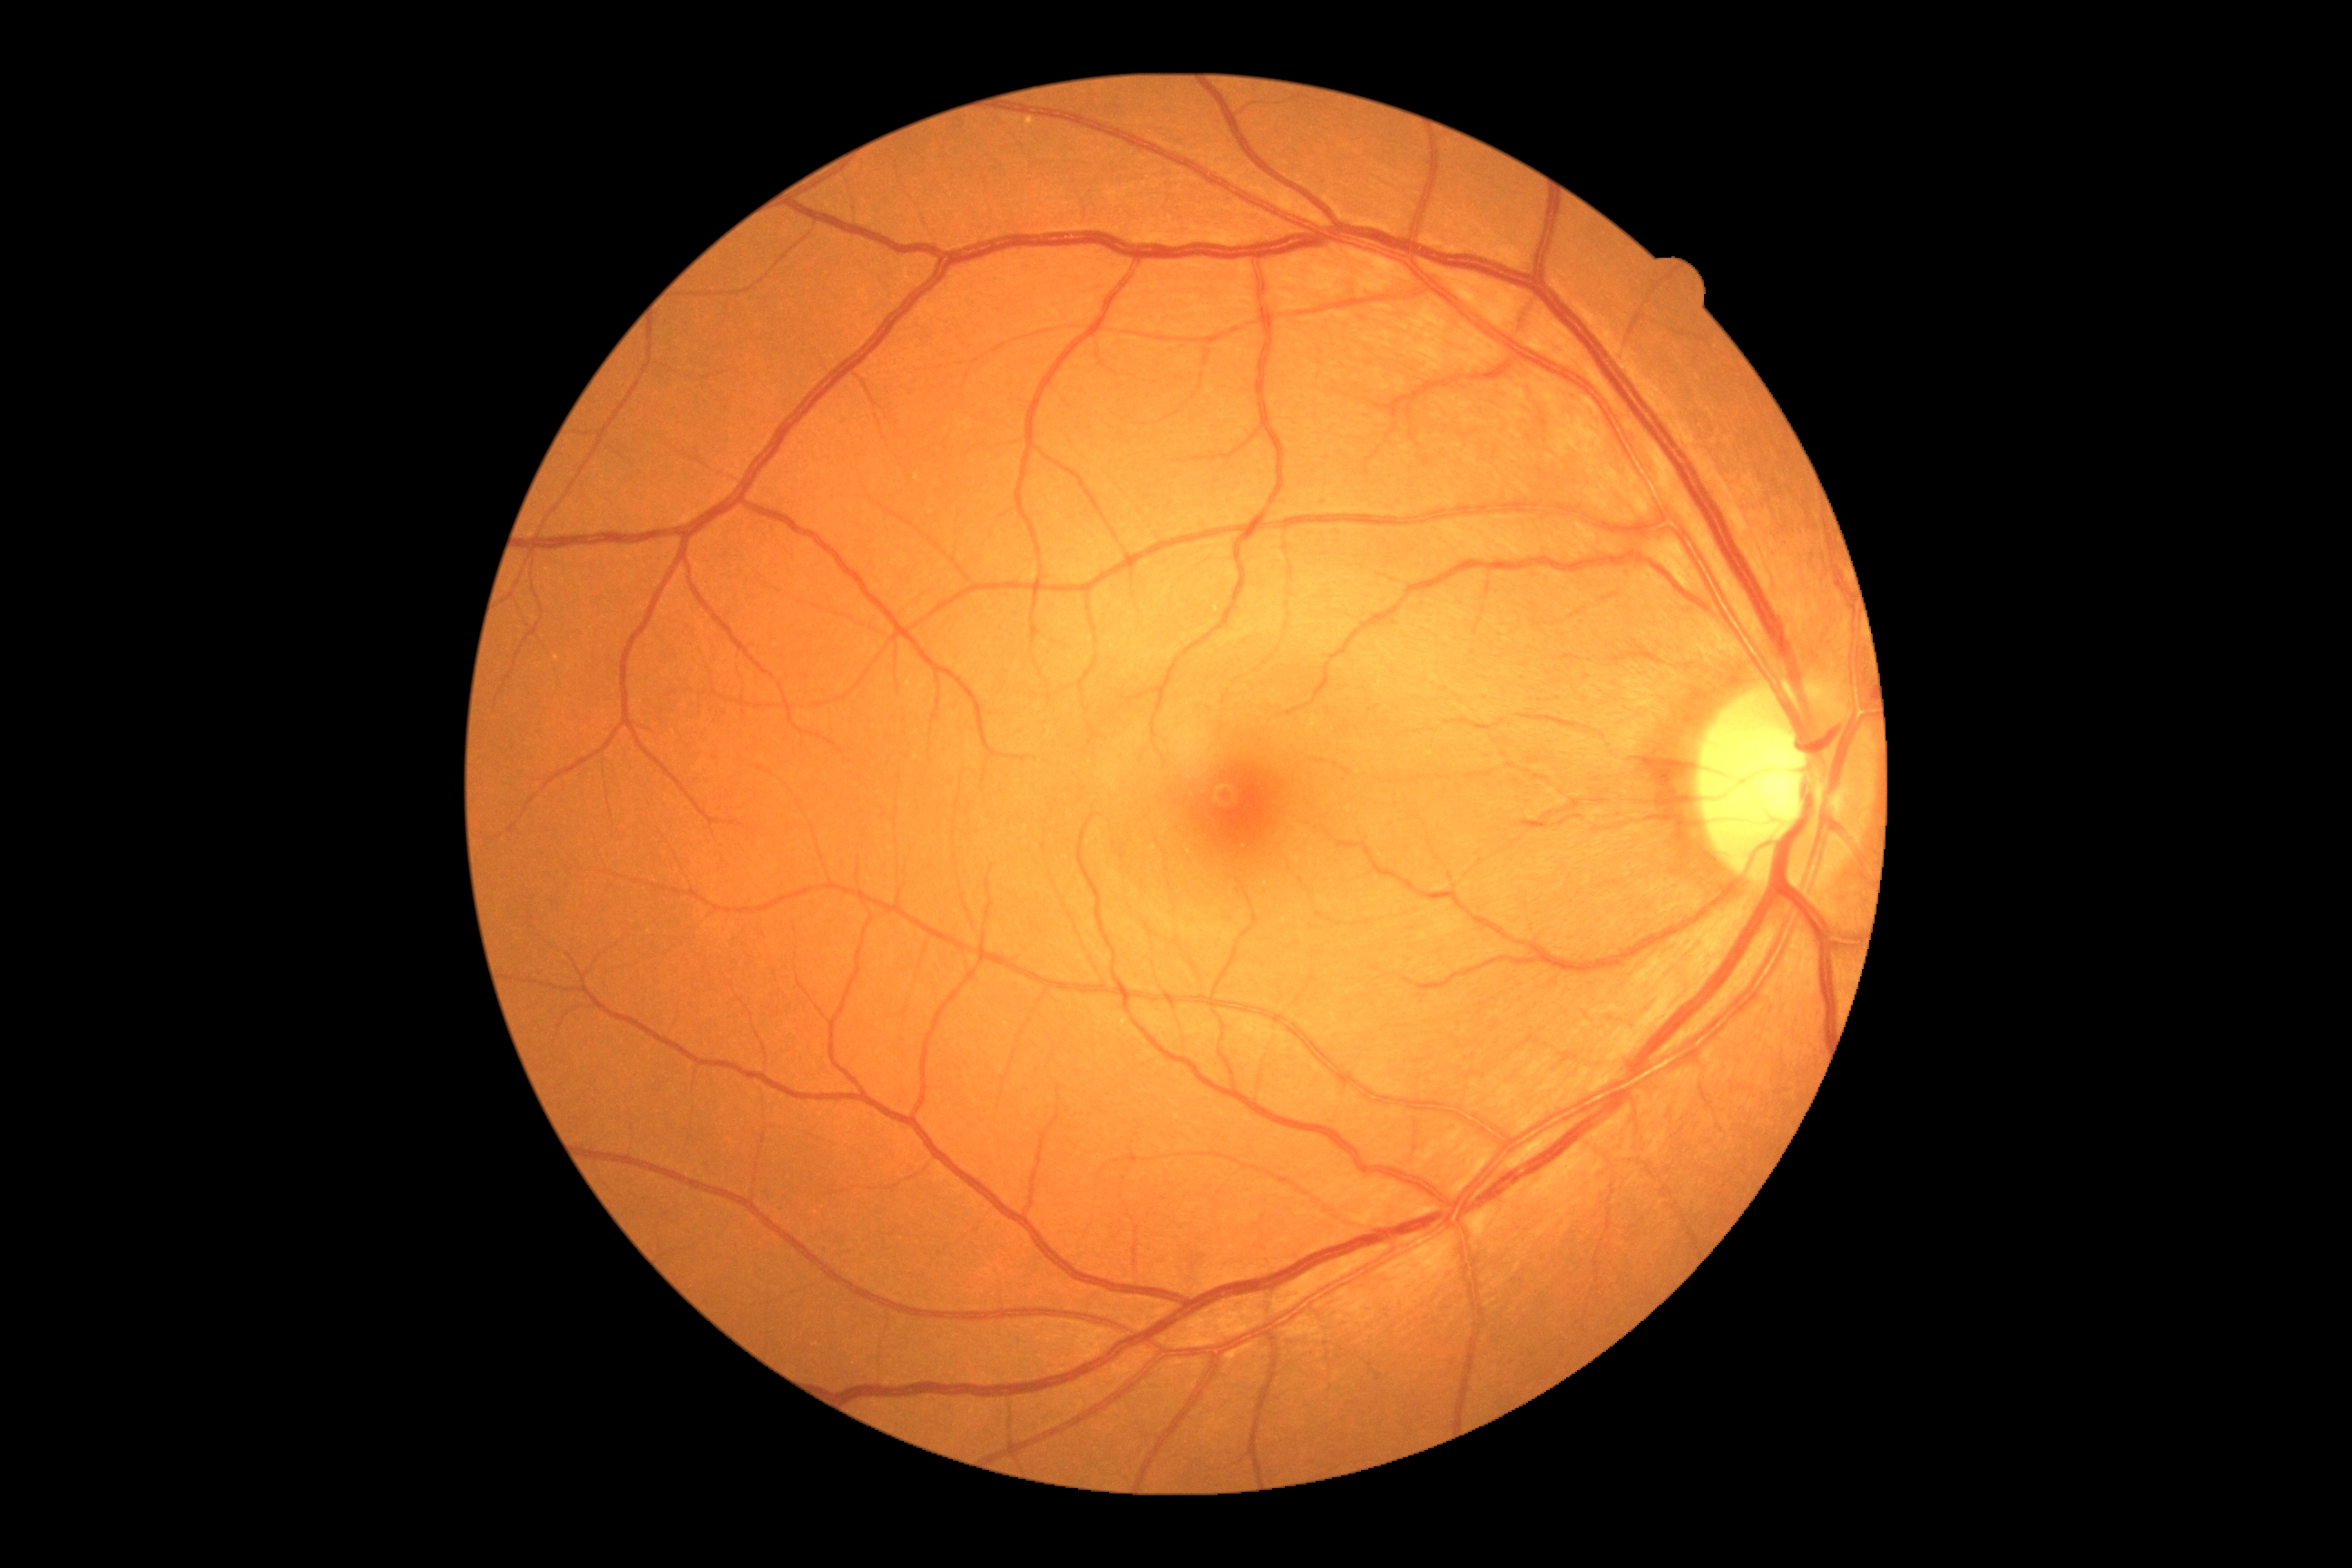
No diabetic retinal disease findings. Retinopathy grade: no apparent diabetic retinopathy (0).